CFP — 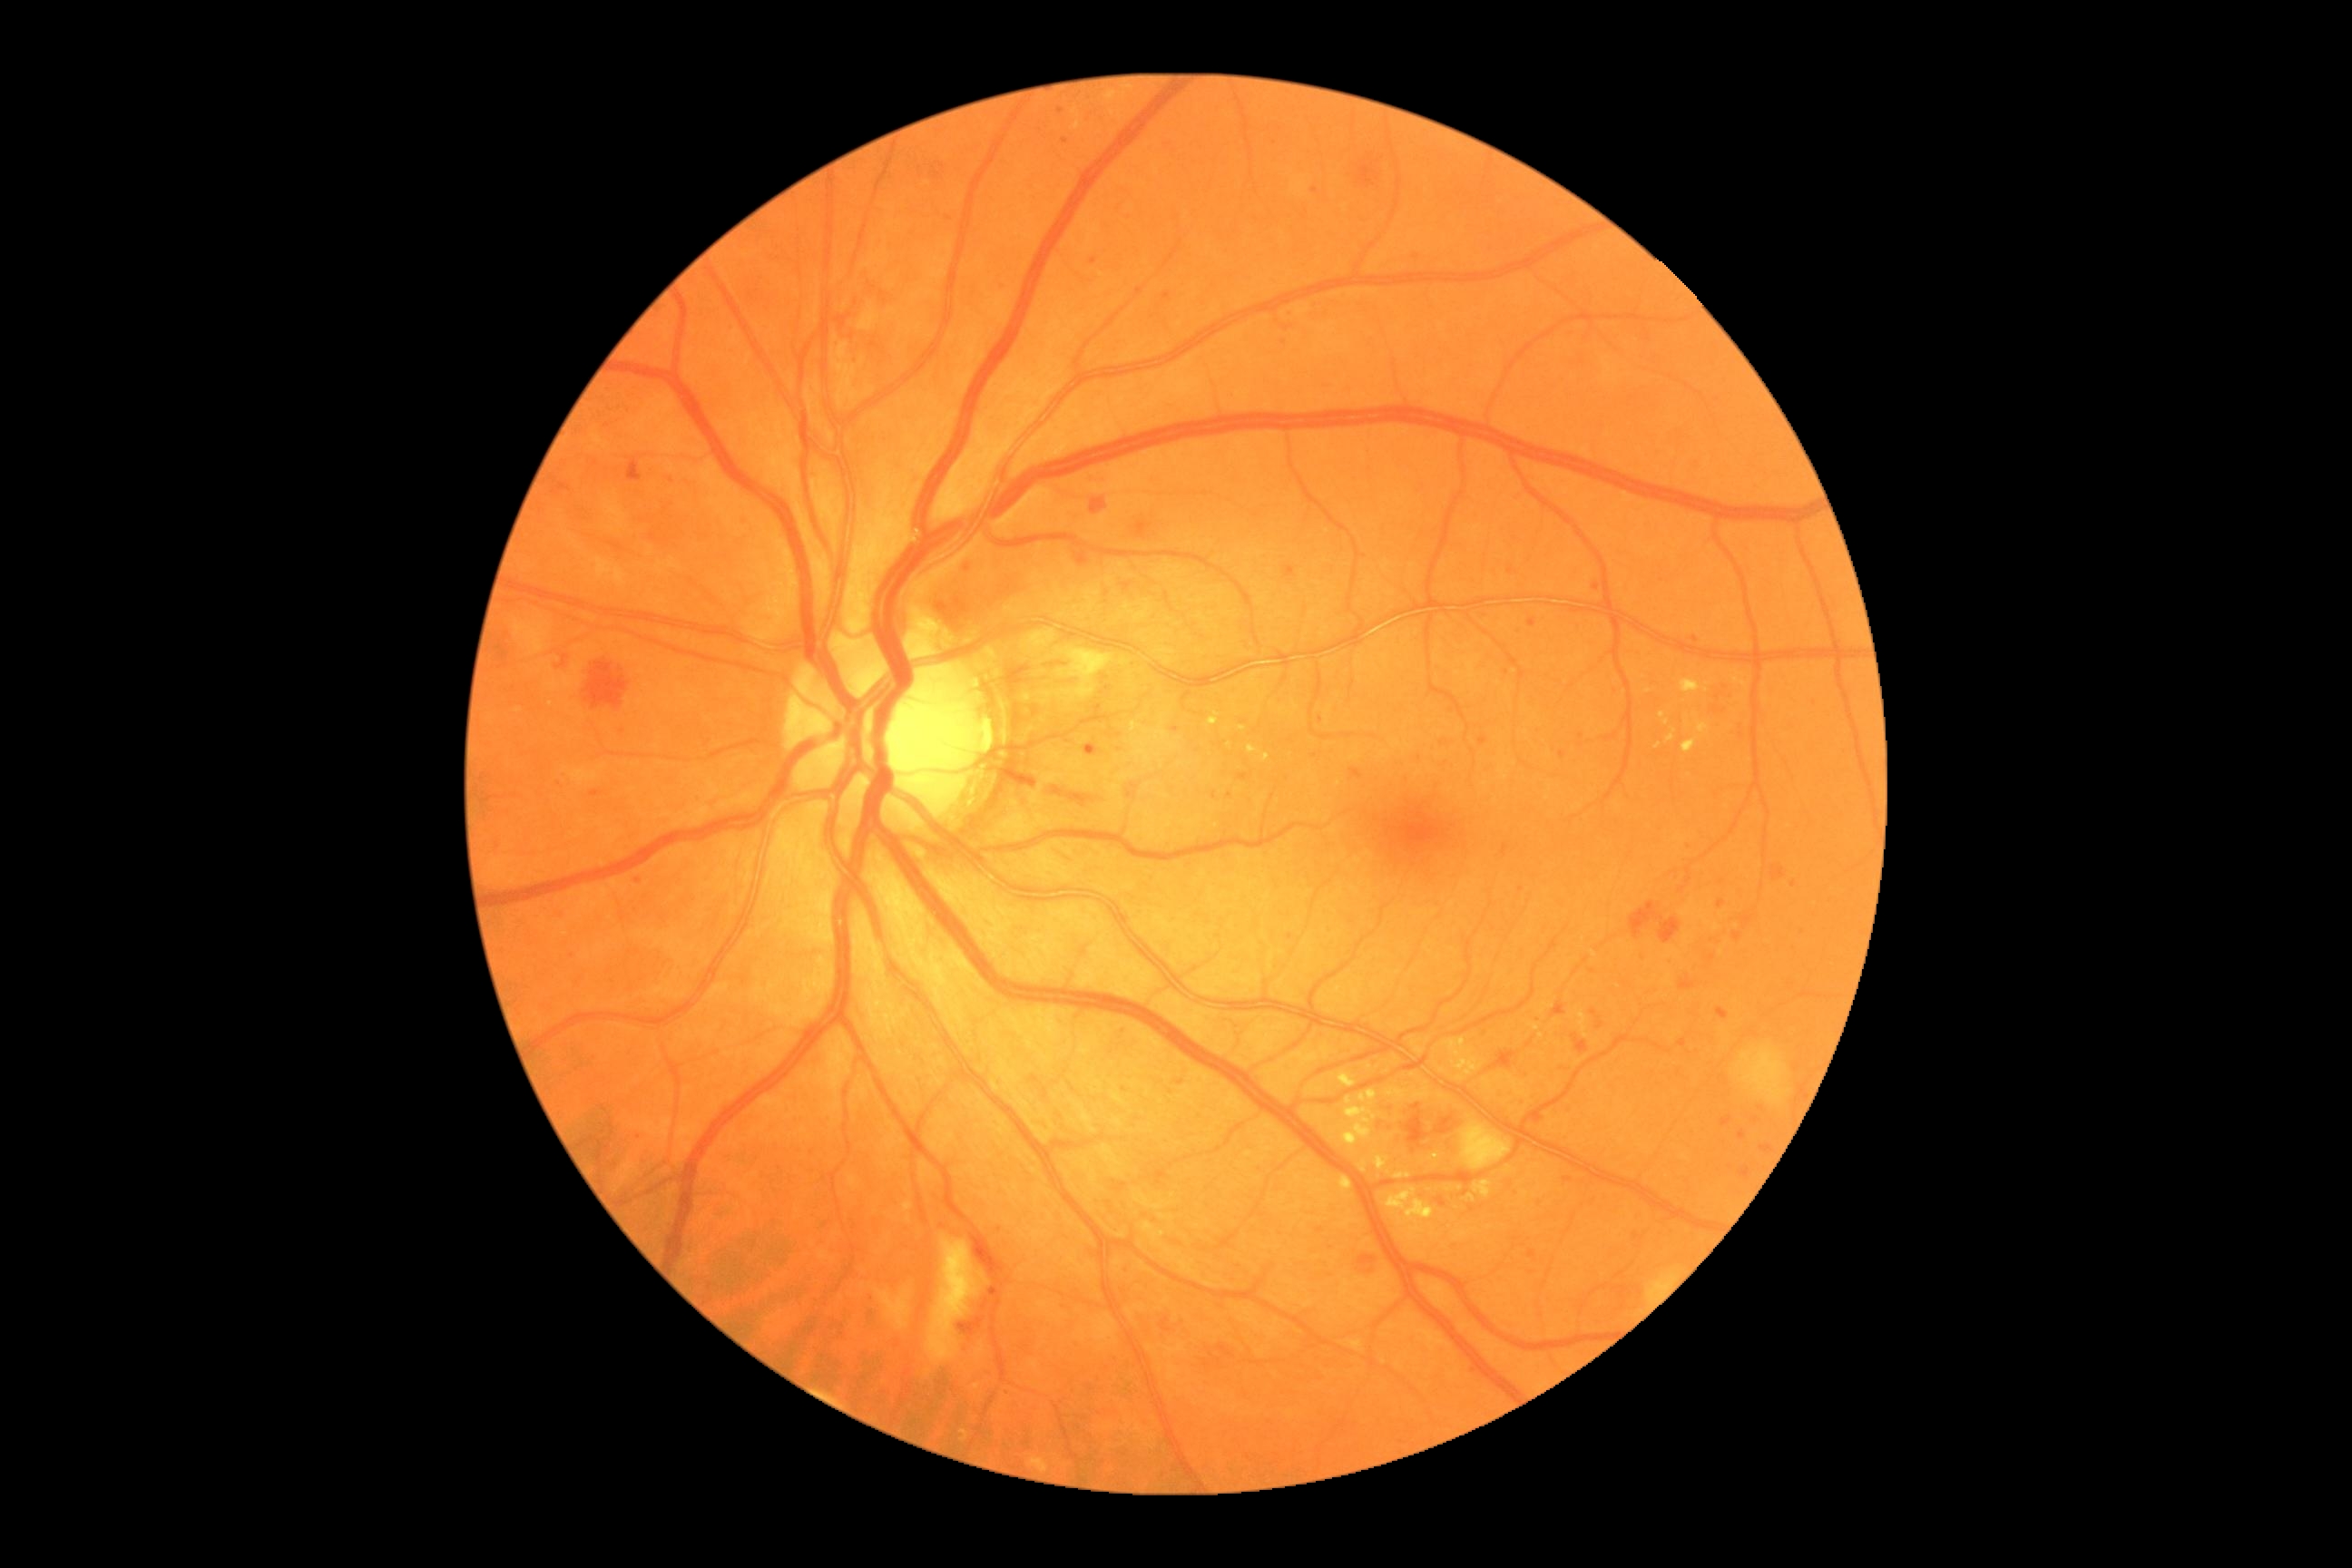 Diabetic retinopathy (DR): grade 3
A subset of detected lesions:
• microaneurysms (MAs) (more not shown): BBox(1592, 583, 1602, 593), BBox(1565, 1179, 1573, 1184), BBox(1529, 618, 1536, 629), BBox(636, 876, 642, 885)
• Additional small MAs near (x=1061, y=111), (x=623, y=917), (x=1581, y=736), (x=1290, y=937), (x=1274, y=142), (x=1472, y=1210), (x=1511, y=571), (x=1093, y=262), (x=1284, y=342), (x=671, y=481), (x=572, y=955), (x=1174, y=731), (x=1693, y=847)